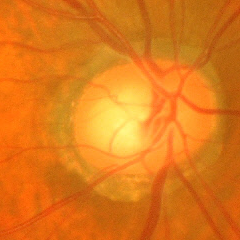

Glaucomatous changes are present.
Advanced glaucoma.